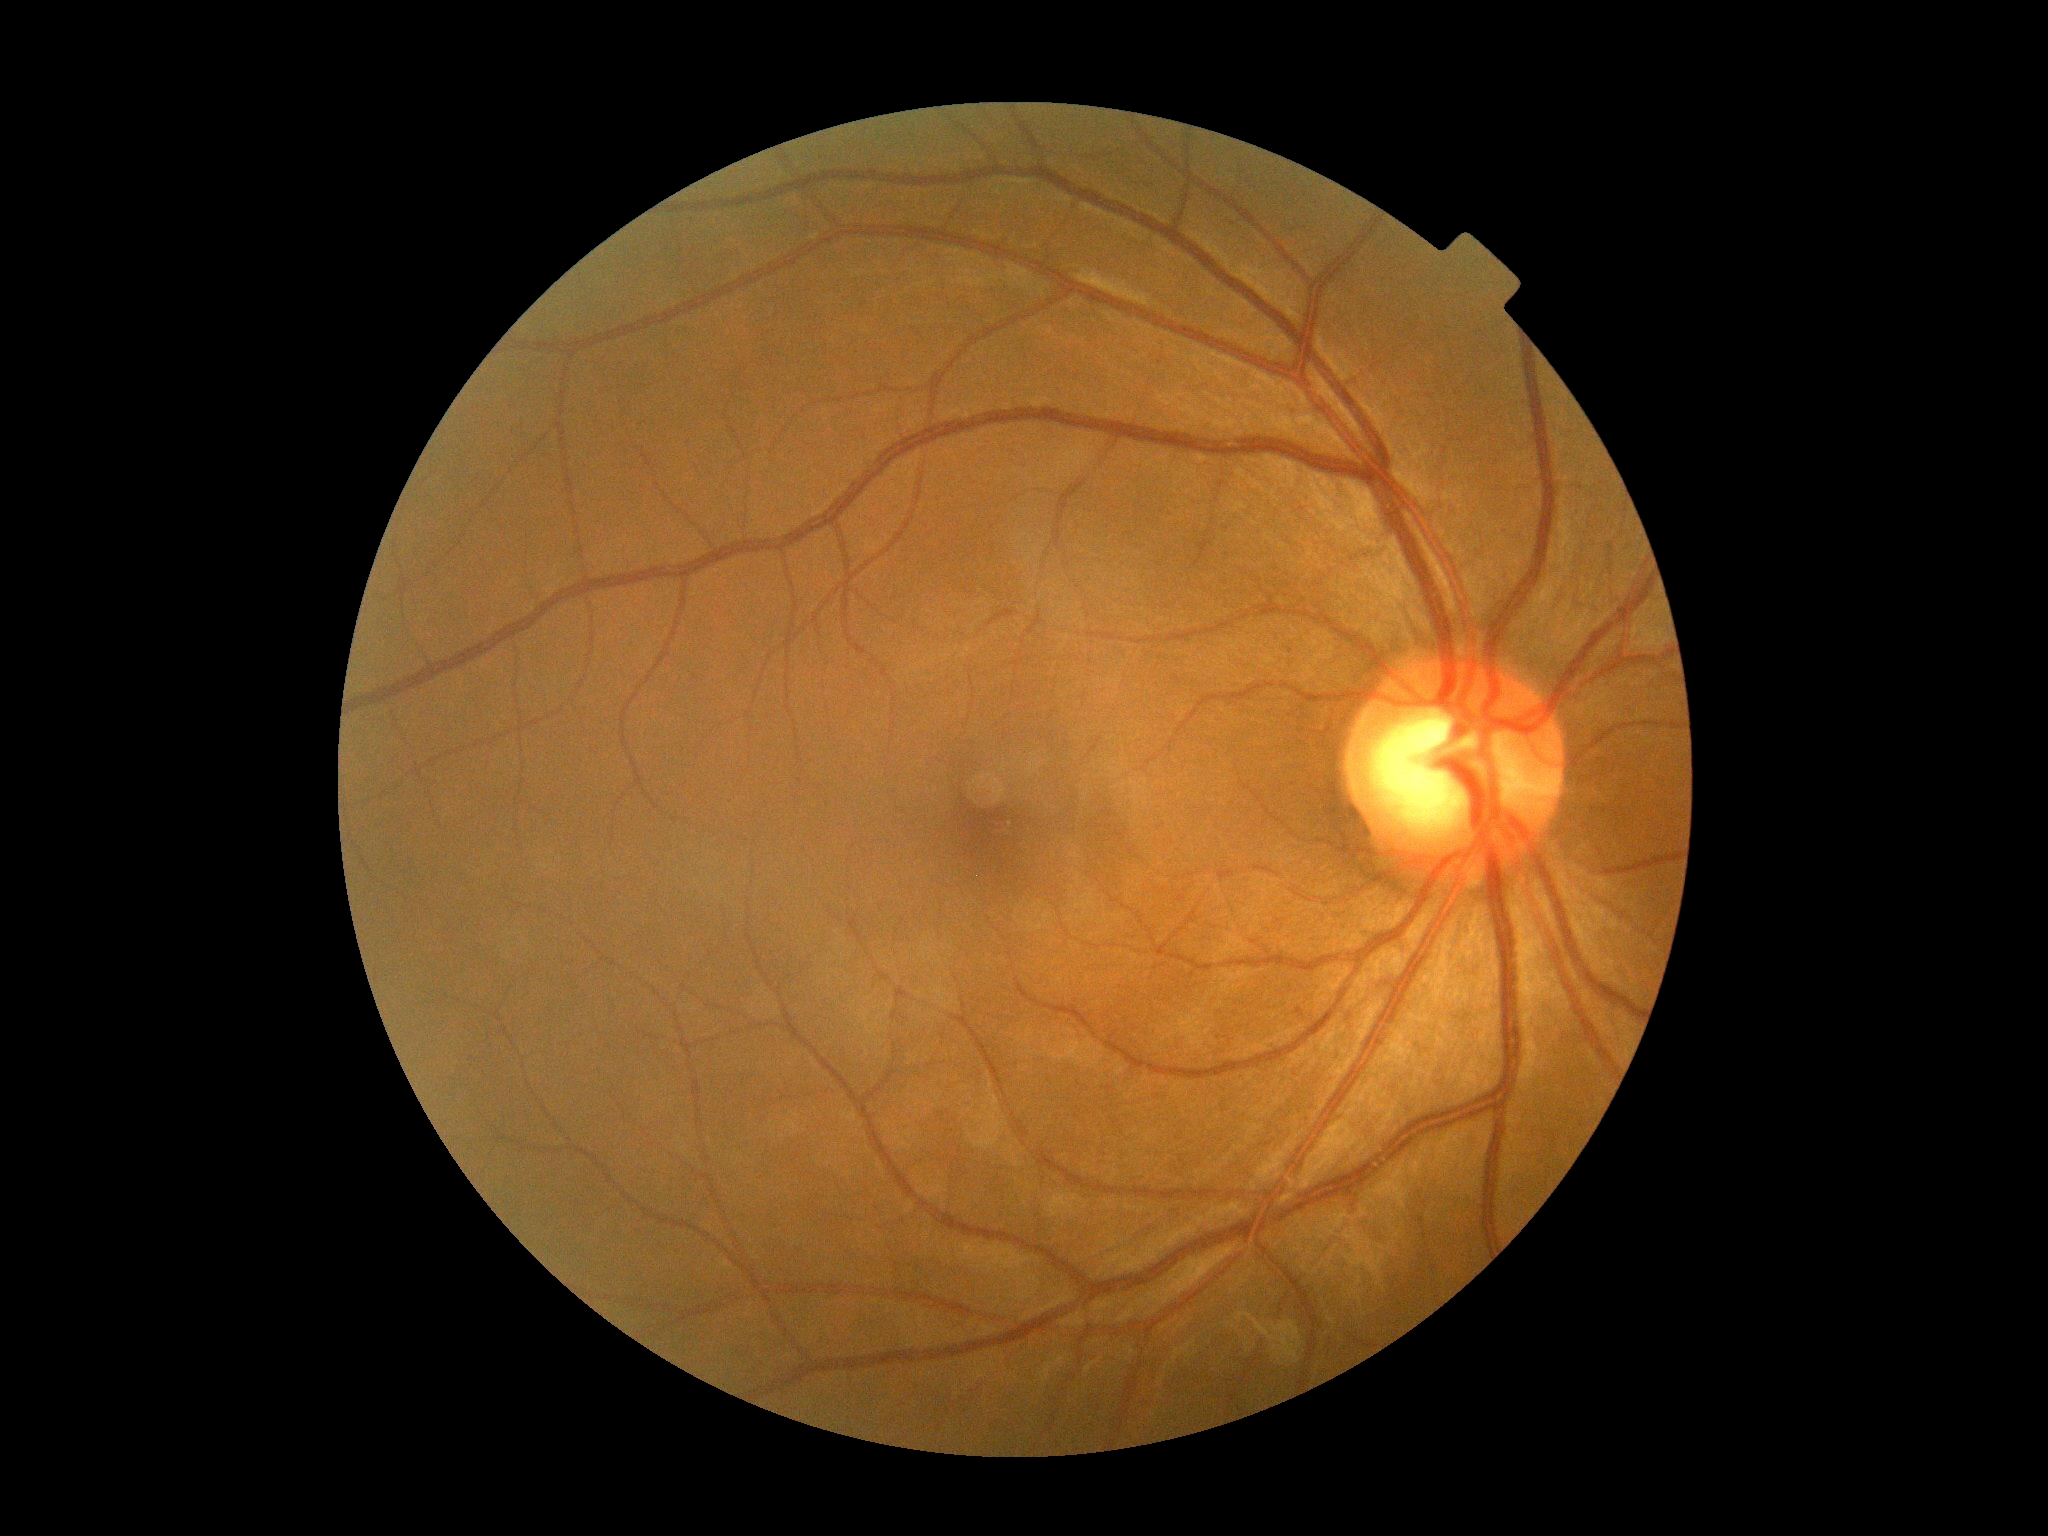 – diabetic retinopathy (DR) — no apparent diabetic retinopathy (grade 0)